640 x 480 pixels. Wide-field contact fundus photograph of an infant — 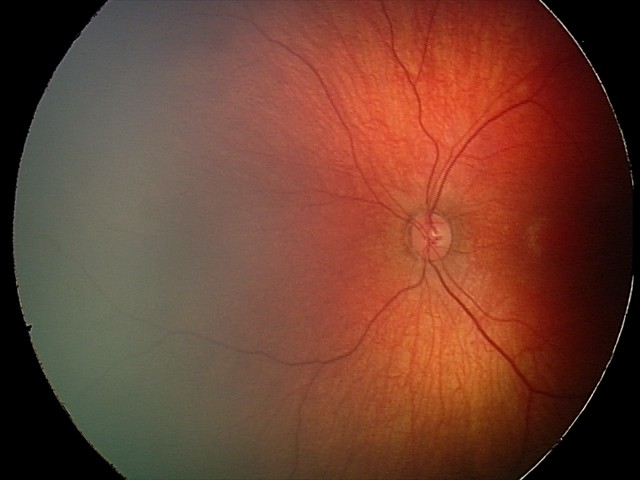 Screening examination consistent with retinal hemorrhages.